Image size 848x848. No pharmacologic dilation: 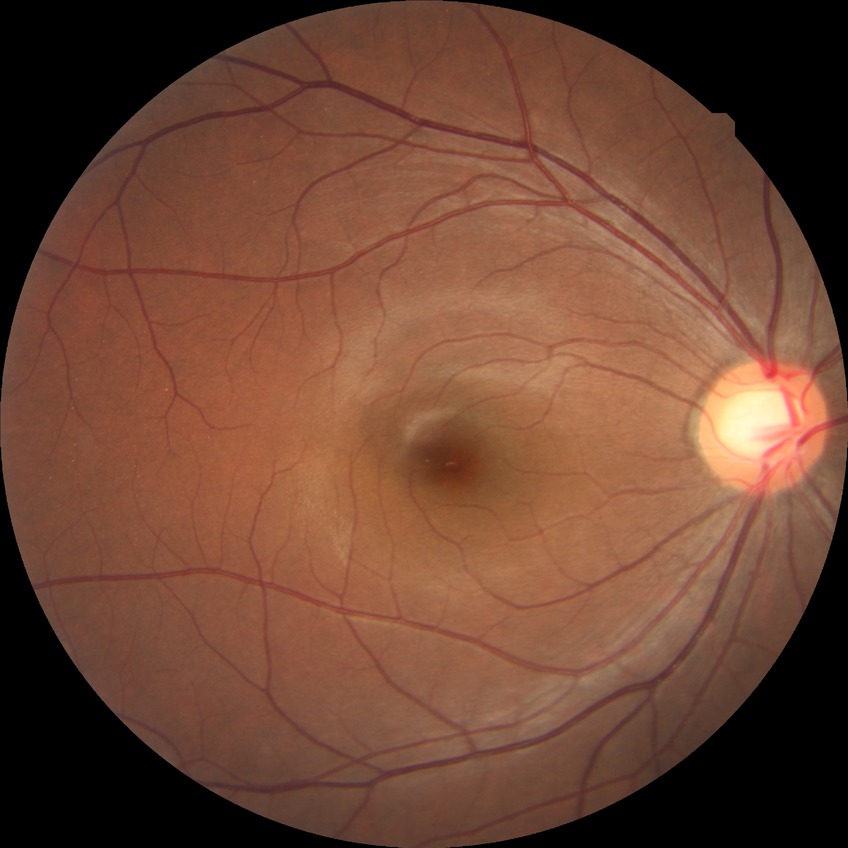 DR is NDR.